Posterior pole photograph.
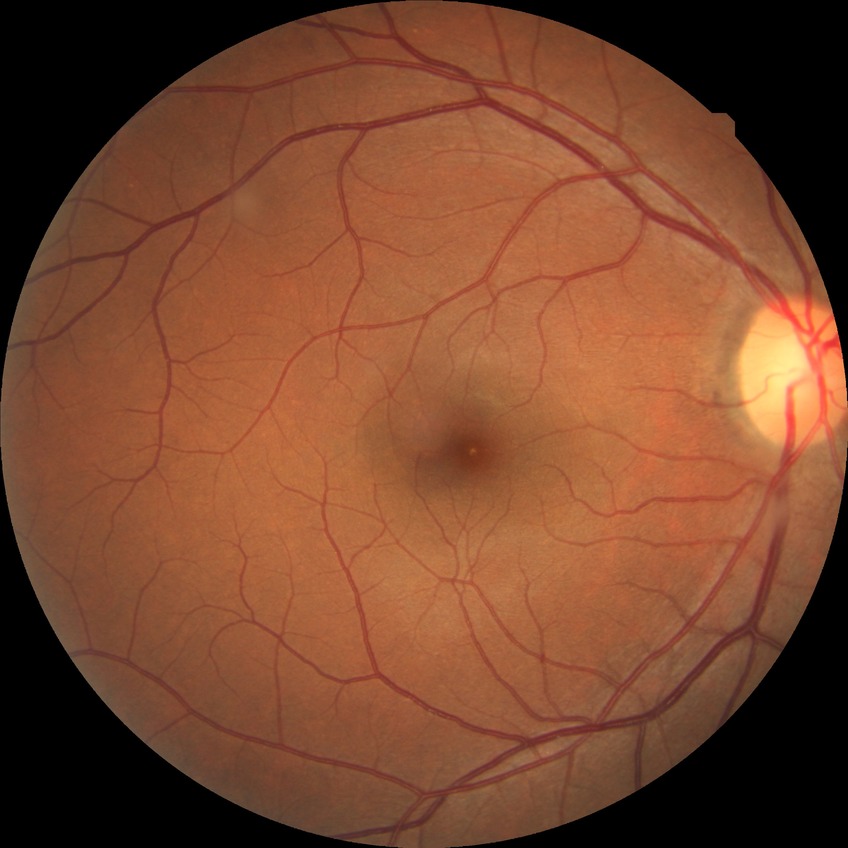 Retinopathy grade: no diabetic retinopathy.